Davis DR grading.
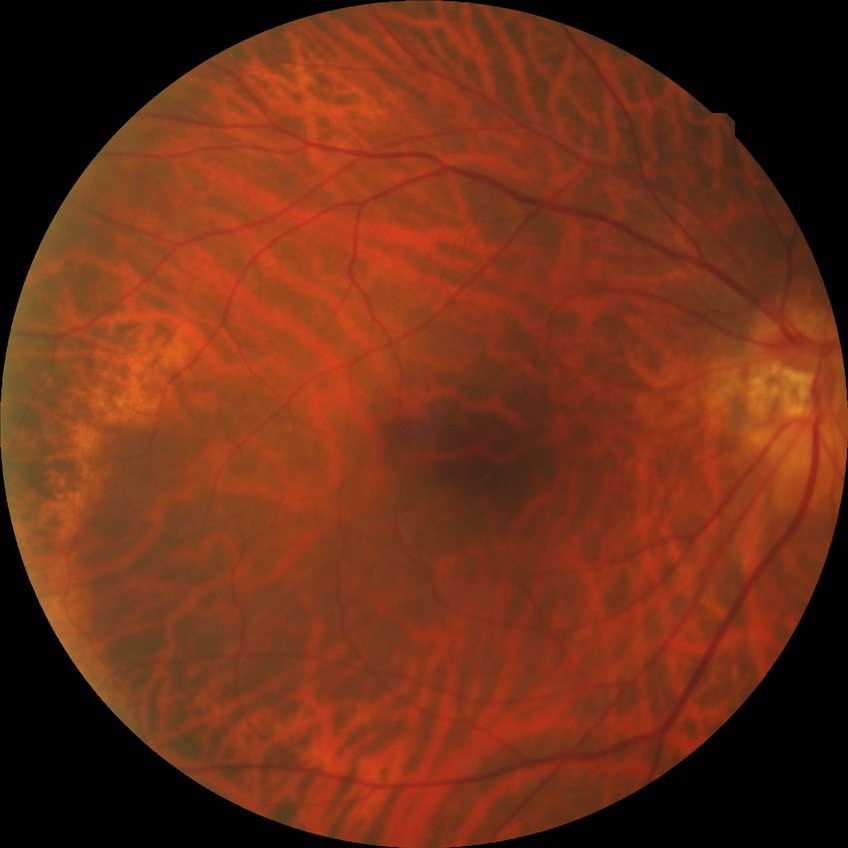

Diabetic retinopathy (DR) is no diabetic retinopathy (NDR).